Color fundus image, Davis DR grading, image size 848x848
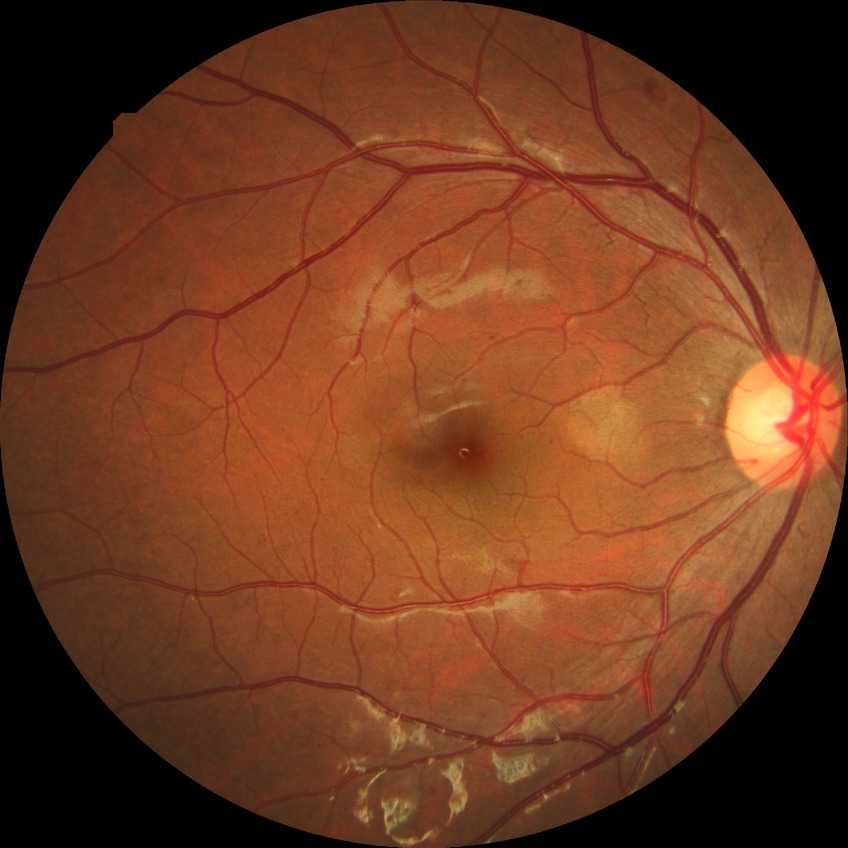 diabetic retinopathy (DR)@SDR (simple diabetic retinopathy); DR class@non-proliferative diabetic retinopathy.